Acquired on the Natus RetCam Envision · infant wide-field fundus photograph — 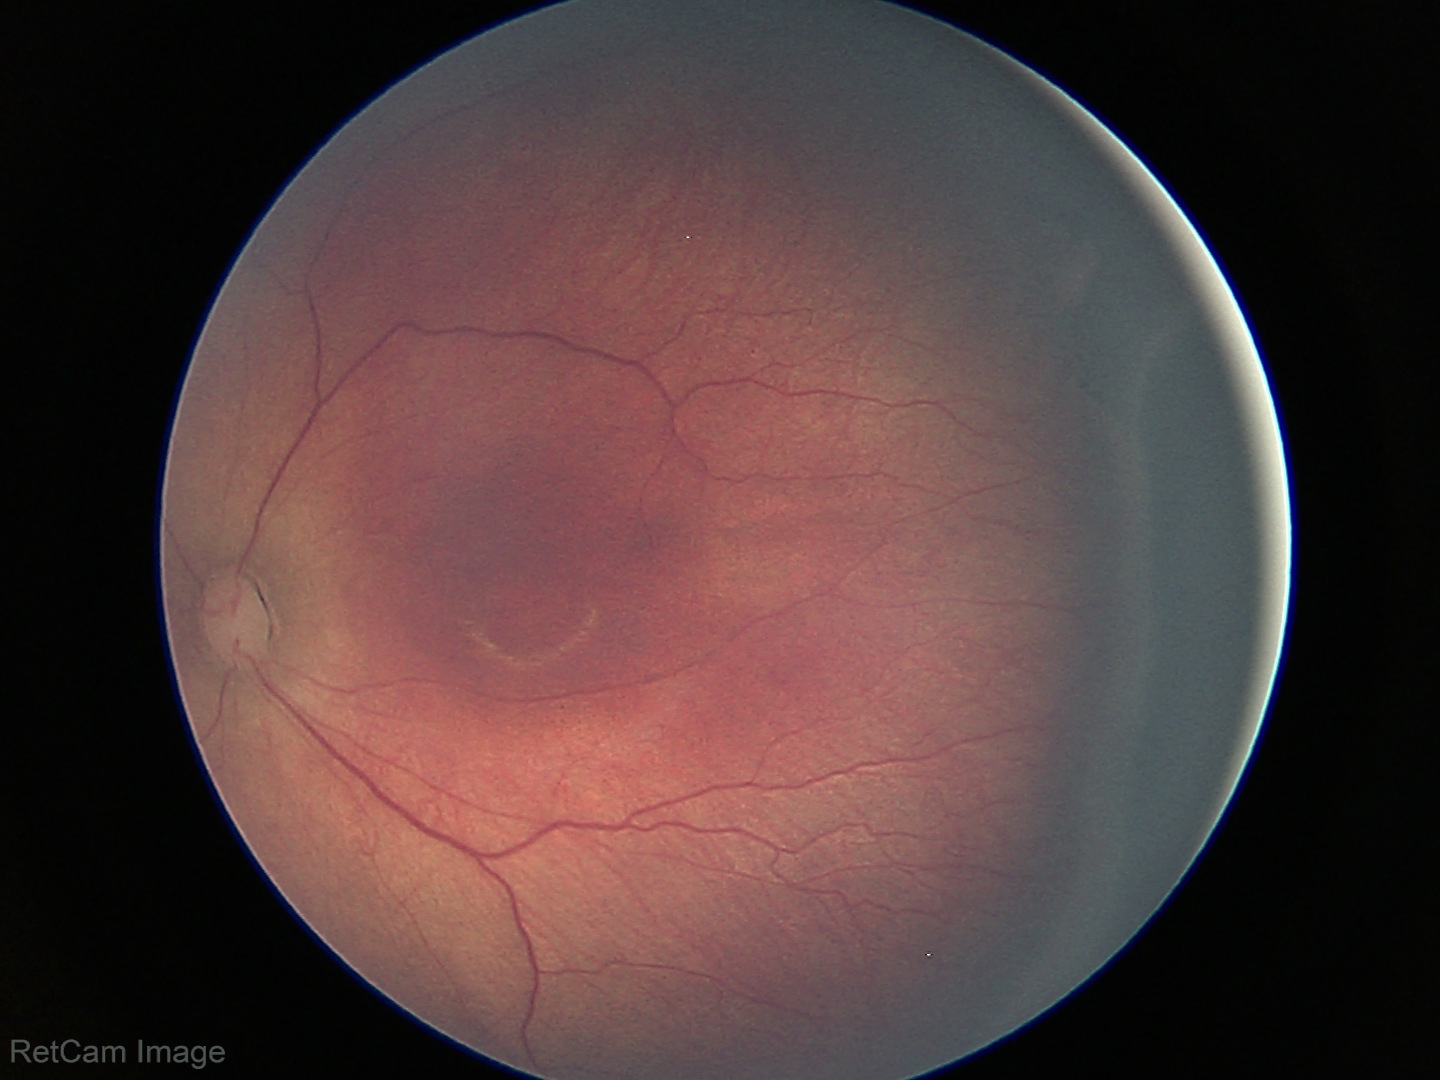
Diagnosis: retinopathy of prematurity (ROP) stage 3.